Camera: Nidek AFC-330 · CFP: 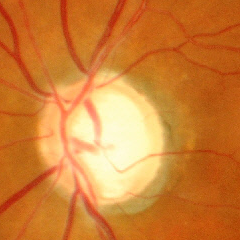
Demonstrates severe glaucomatous damage.